45-degree field of view; CFP:
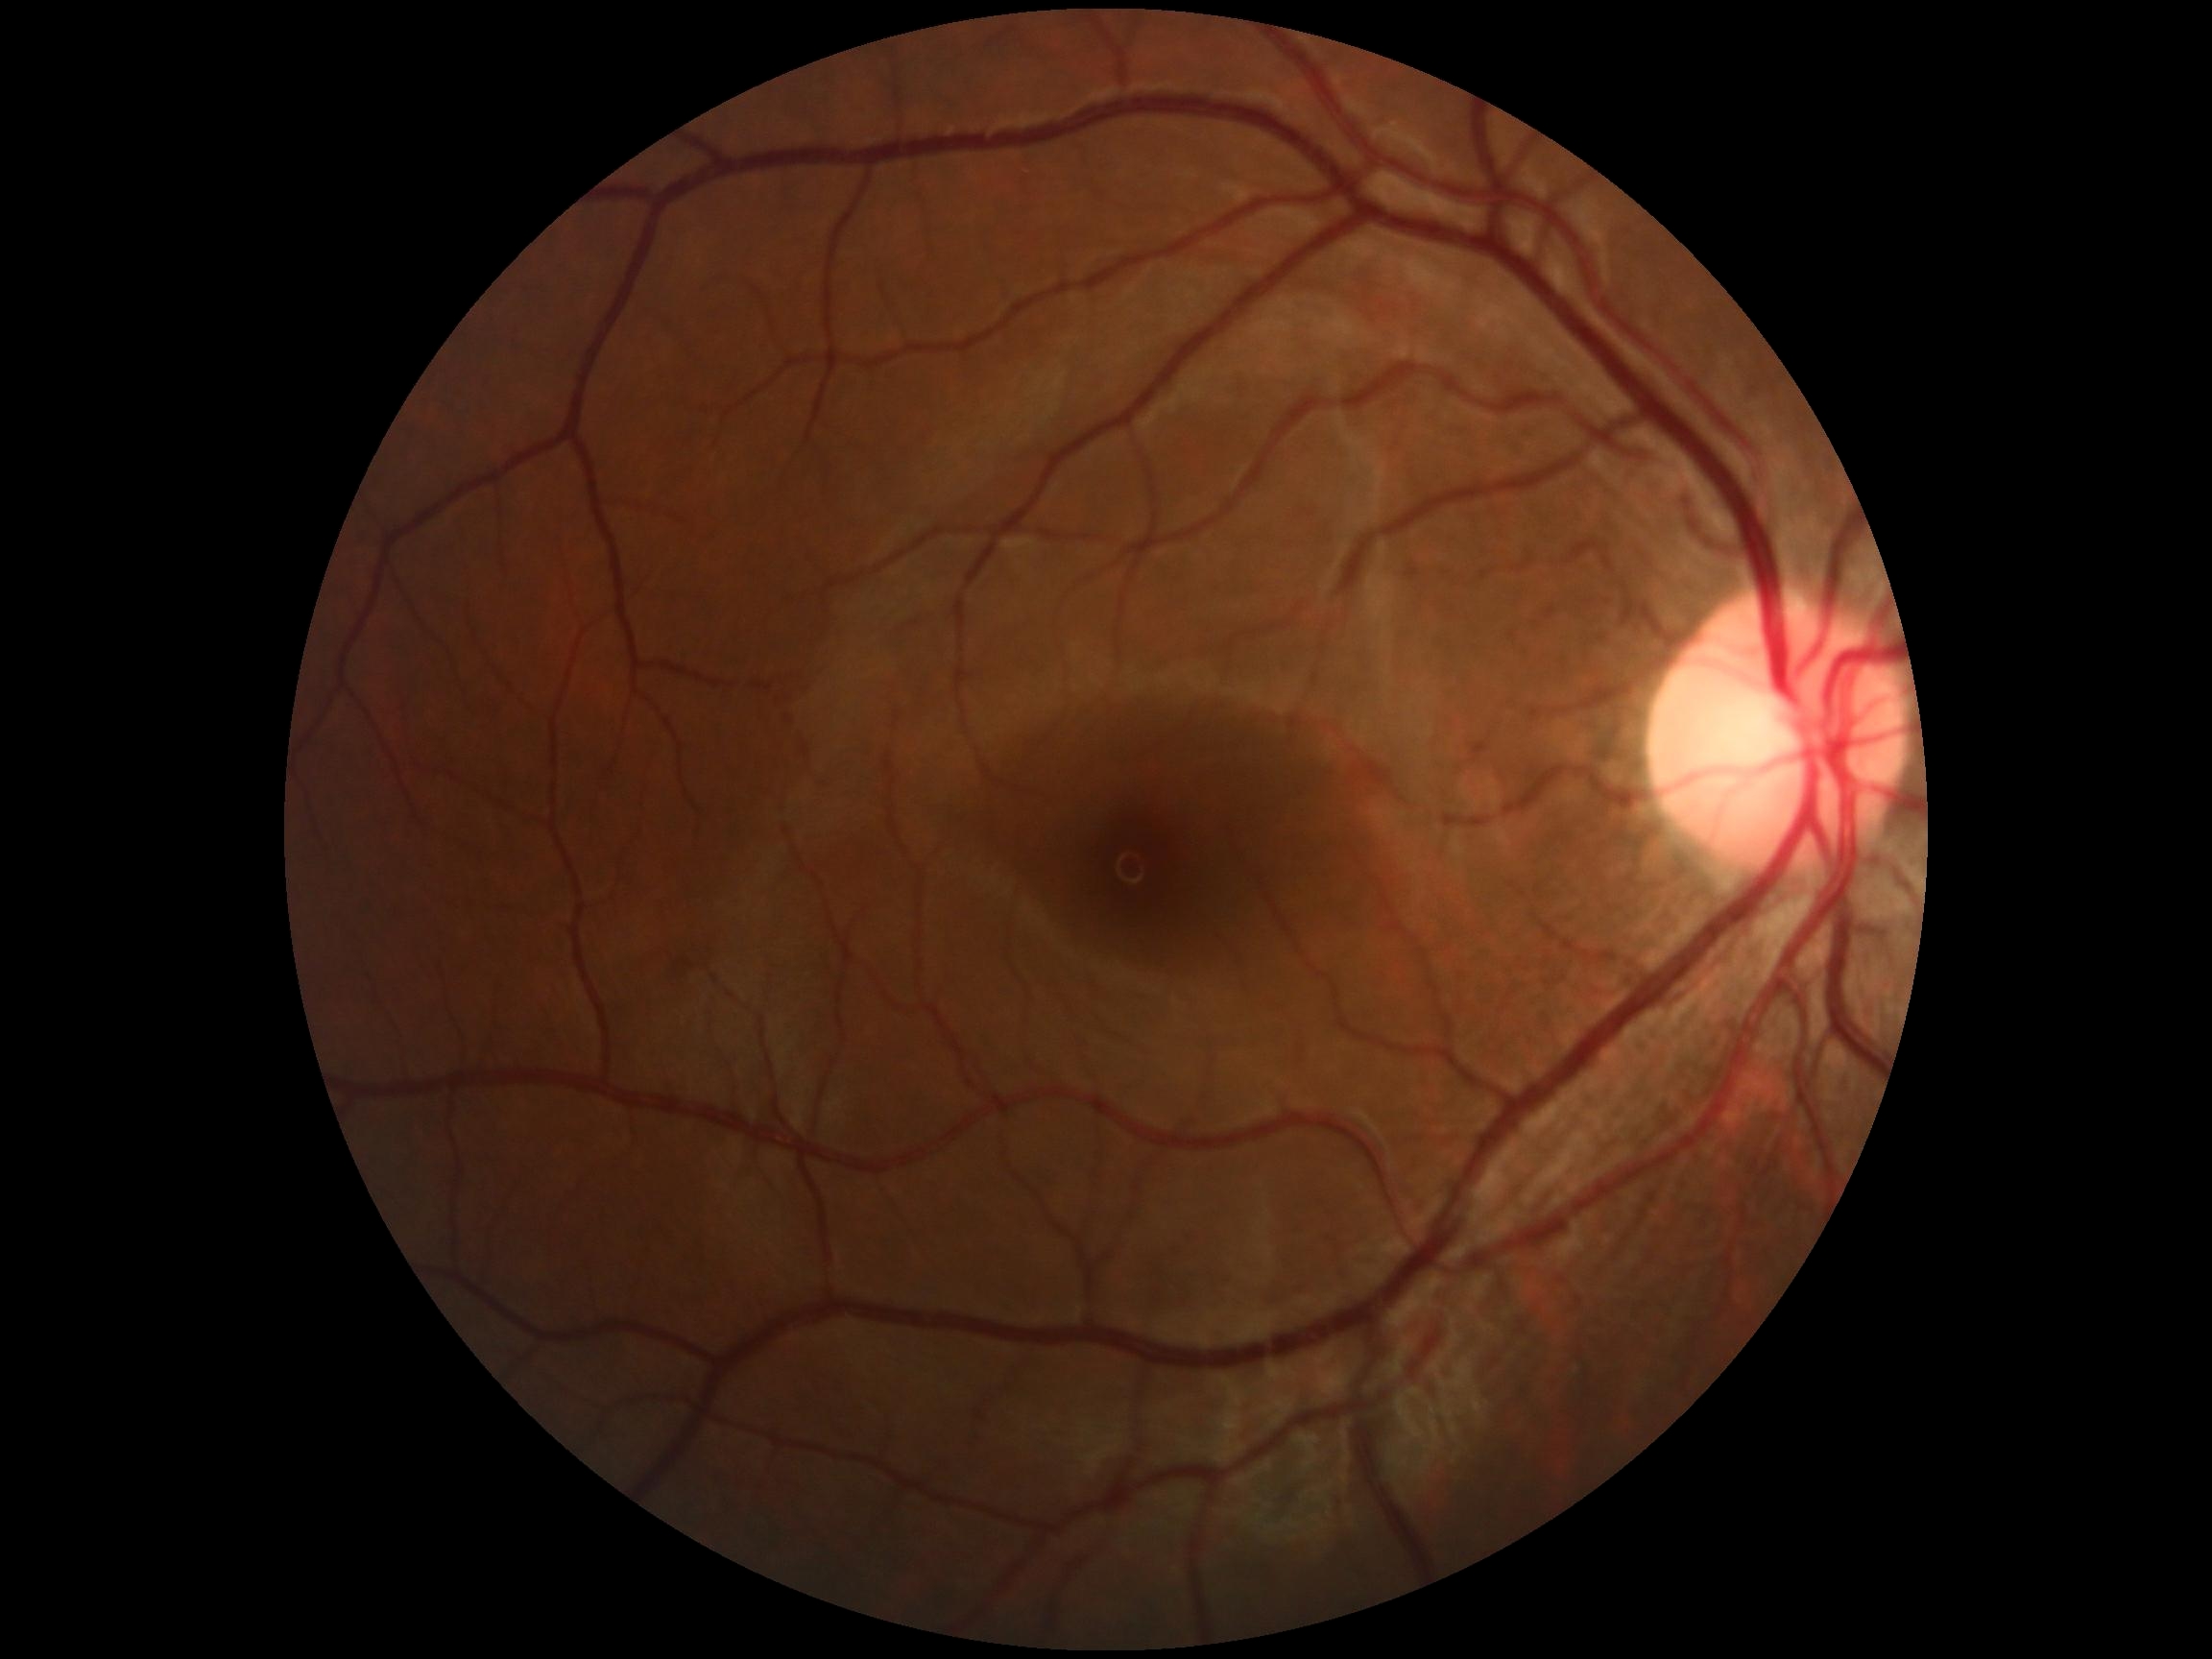 No apparent diabetic retinopathy. DR stage is grade 0 (no apparent retinopathy).